45 degree fundus photograph. Diabetic retinopathy graded by the modified Davis classification. 848 x 848 pixels
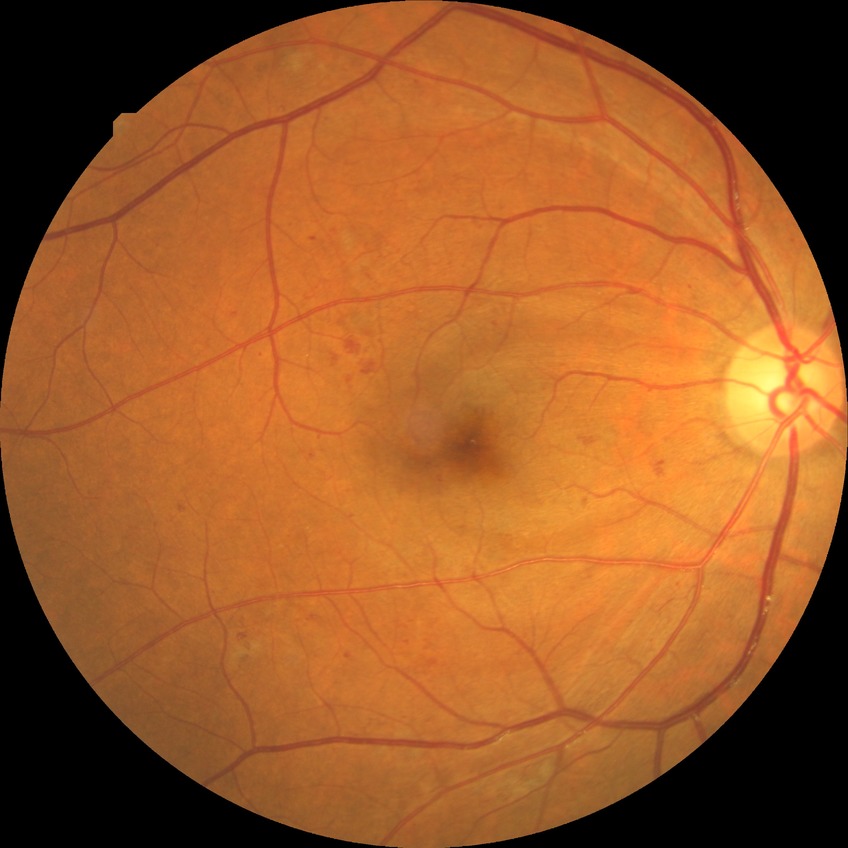 davis_grade: pre-proliferative diabetic retinopathy